1932 by 1932 pixels, acquired with a Topcon TRC-NW8.
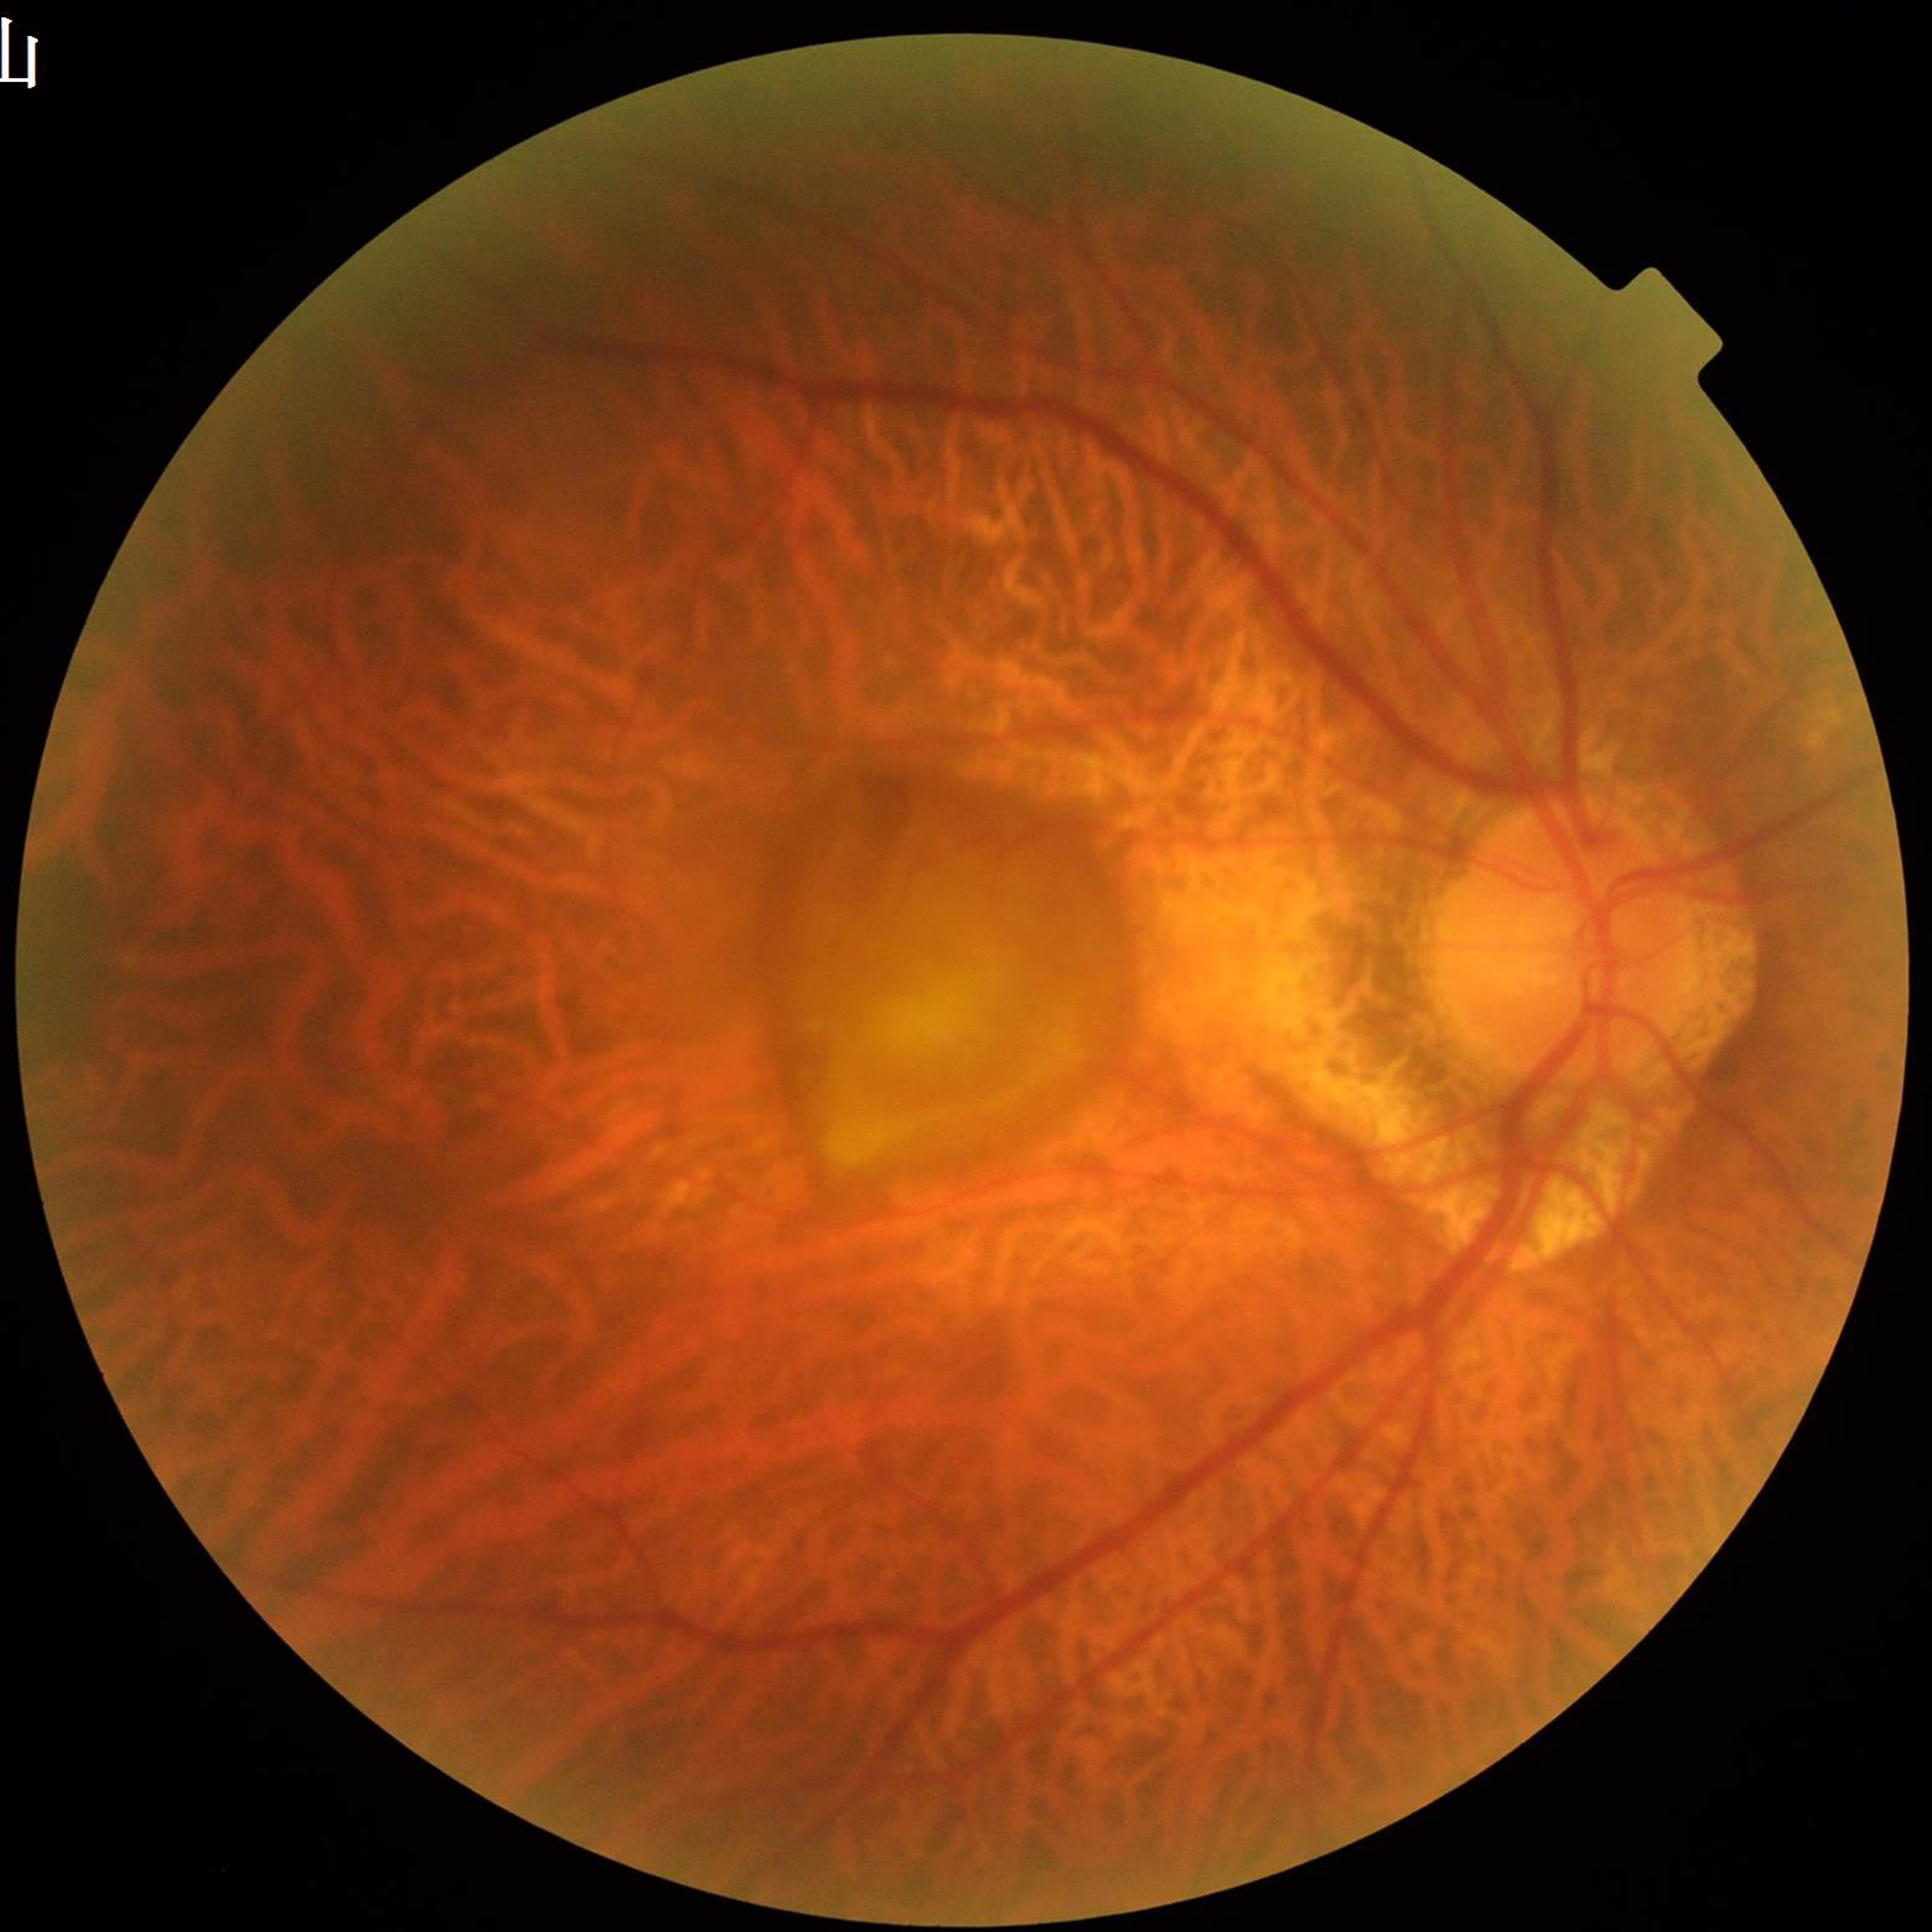

Image quality: illumination and color satisfactory, no blur, contrast adequate. Patient diagnosed with age-related macular degeneration.